Color fundus image. NIDEK AFC-230 fundus camera. 45-degree field of view. 848x848px:
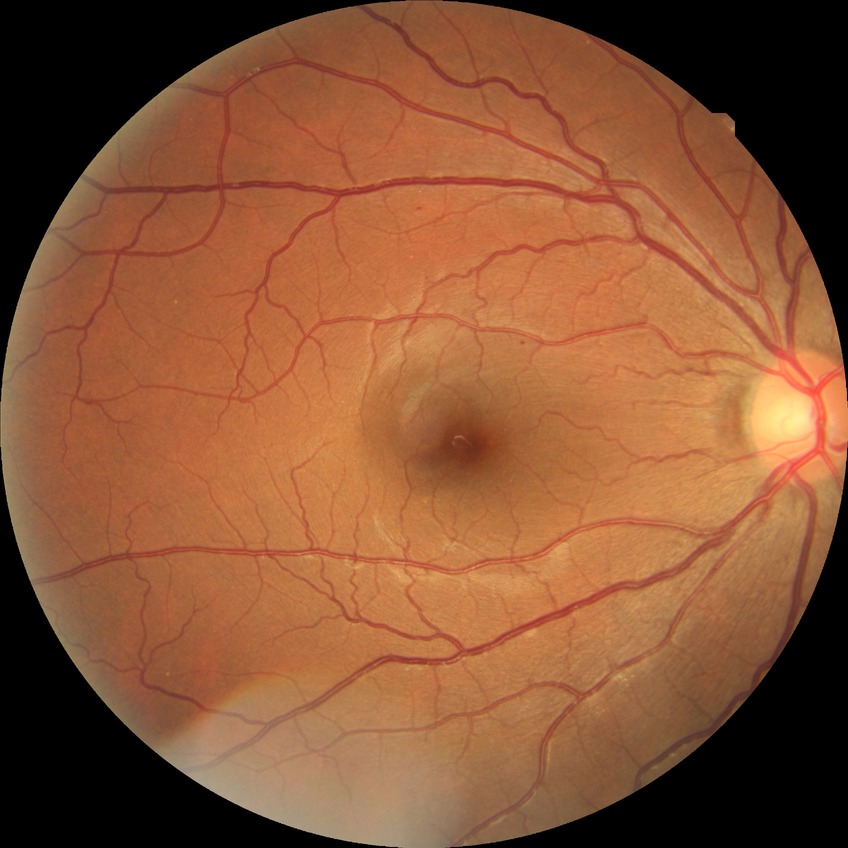

diabetic retinopathy grade@simple diabetic retinopathy.